Retinal fundus photograph:
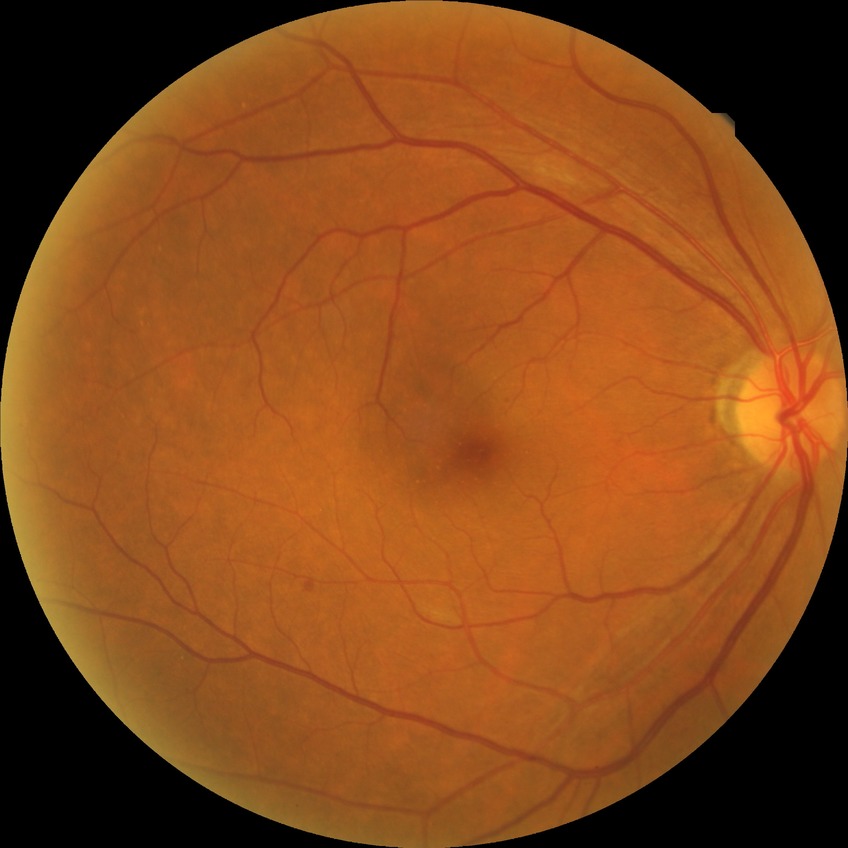 Assessment:
- DR class: non-proliferative diabetic retinopathy
- diabetic retinopathy (DR): simple diabetic retinopathy (SDR)